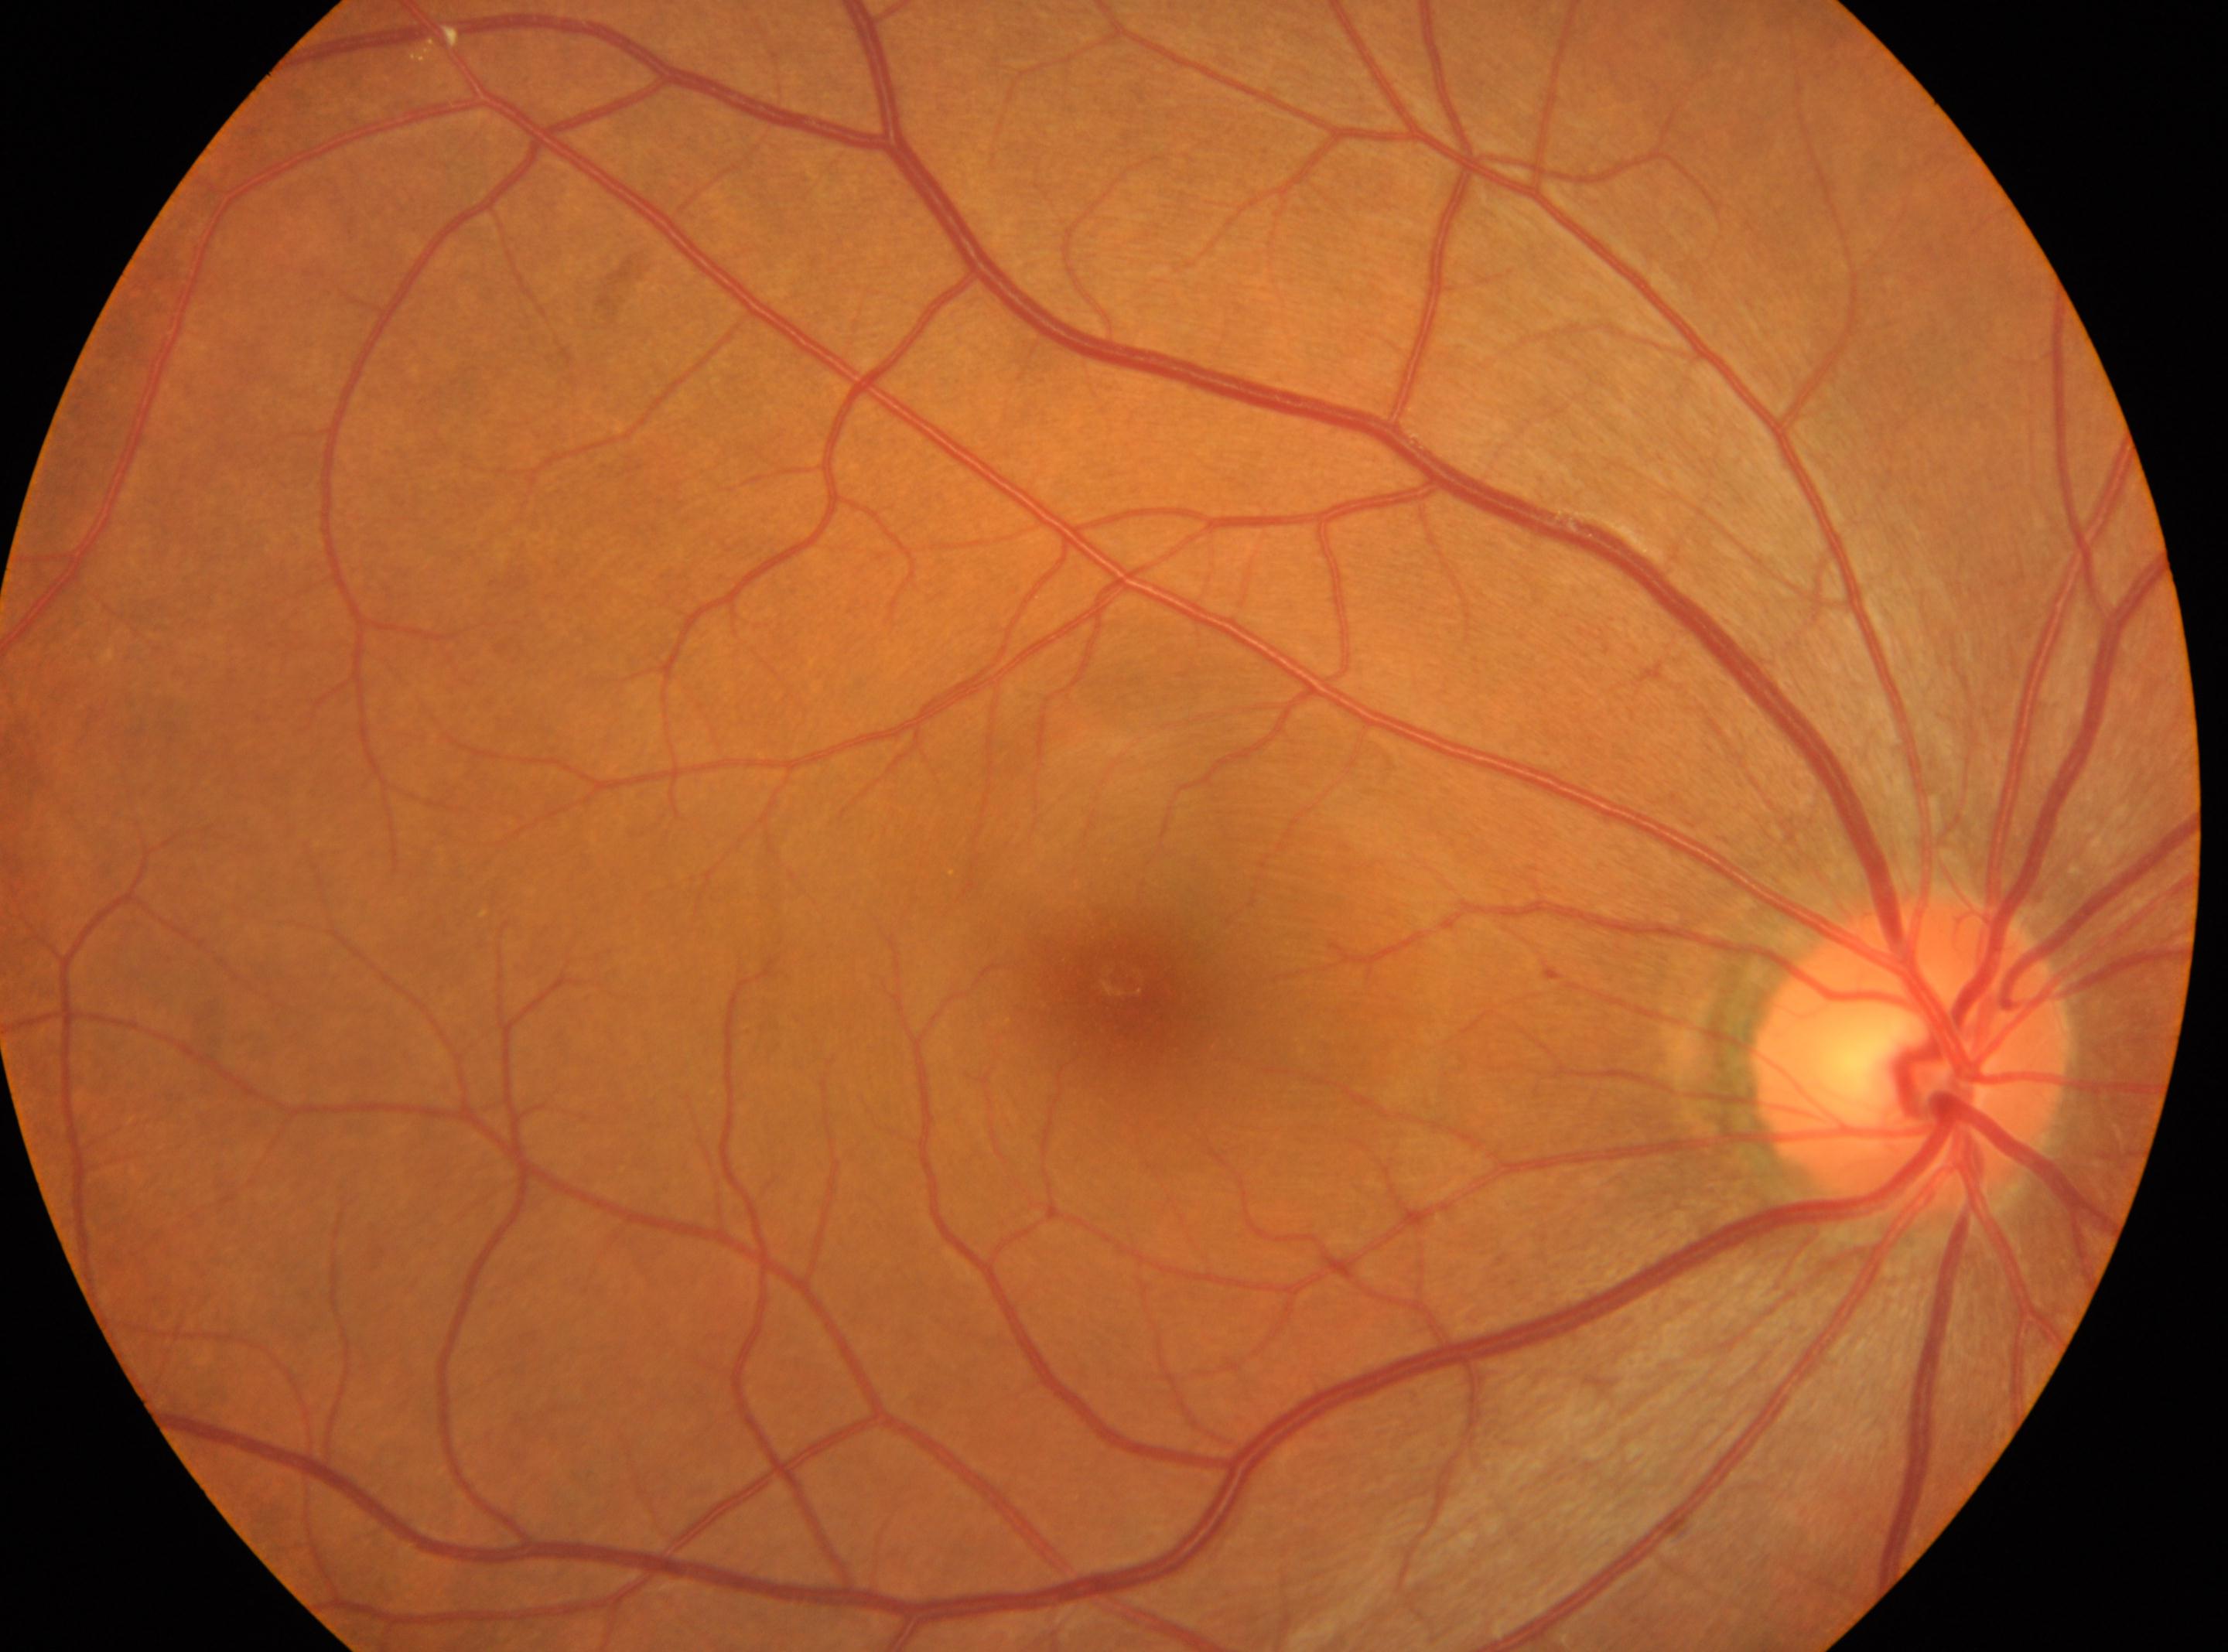

right eye; fovea: (x: 1123, y: 988); diabetic retinopathy: grade 0 (no apparent retinopathy) — no visible signs of diabetic retinopathy; disc center: (x: 1910, y: 1057).